Graded on the modified Davis scale — 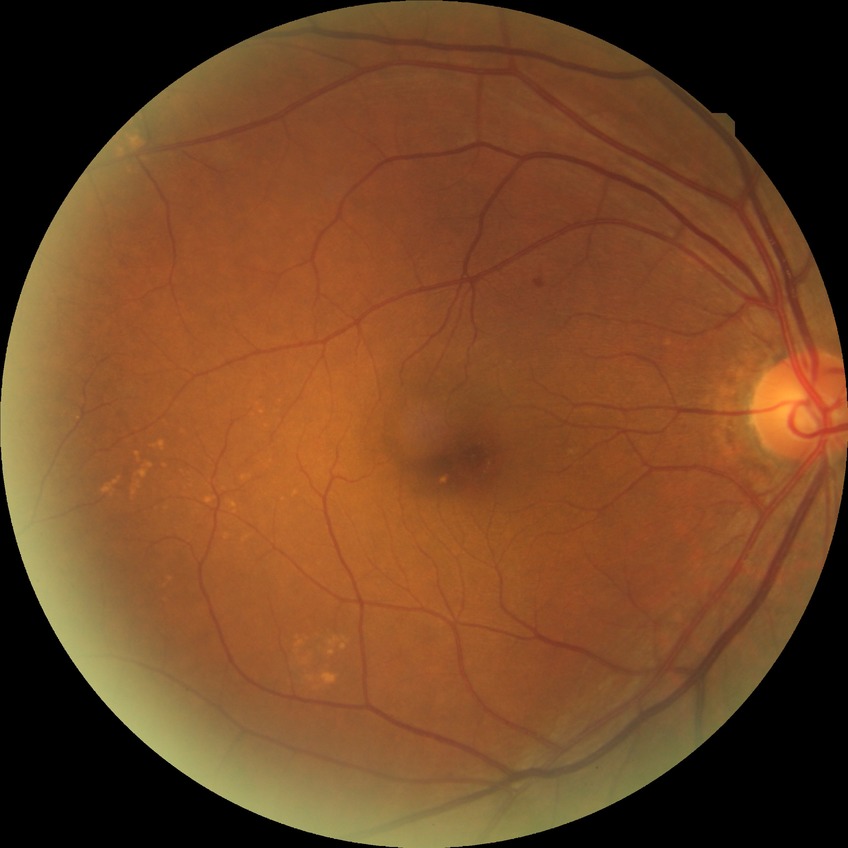

Retinopathy stage is no diabetic retinopathy.